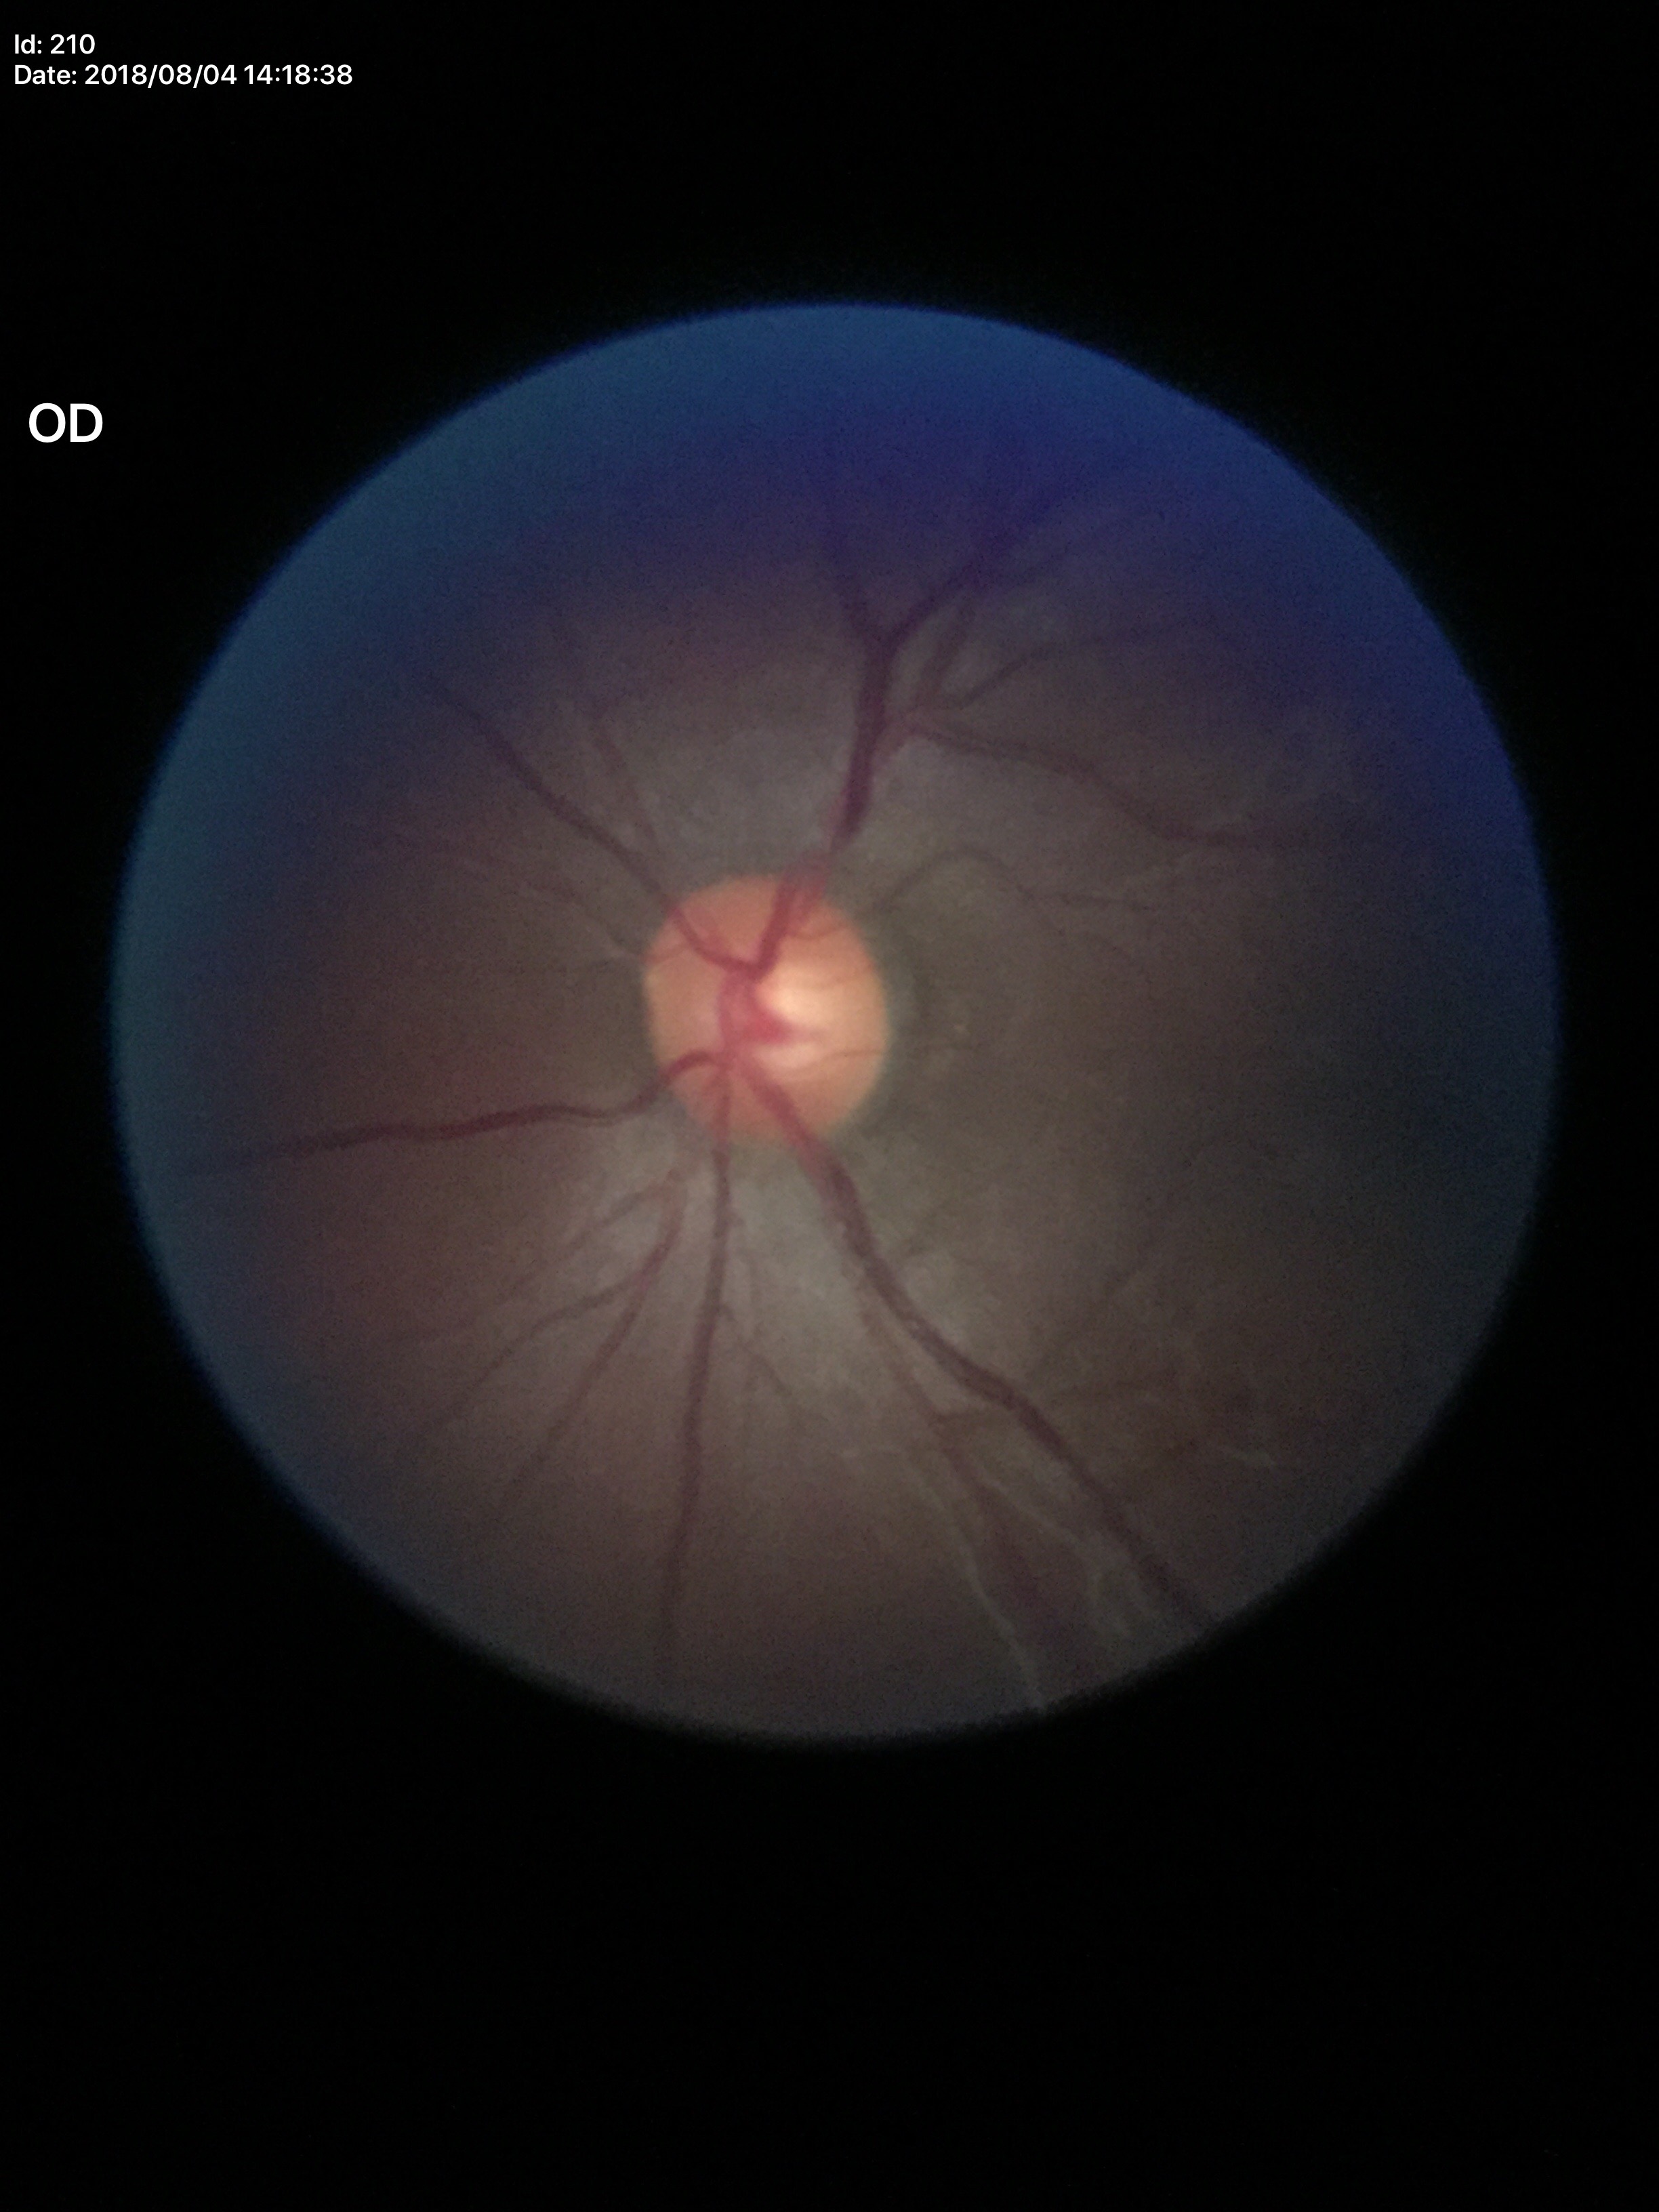
Glaucoma evaluation: not suspect, vertical cup-disc ratio: 0.54, area CDR: 0.31.